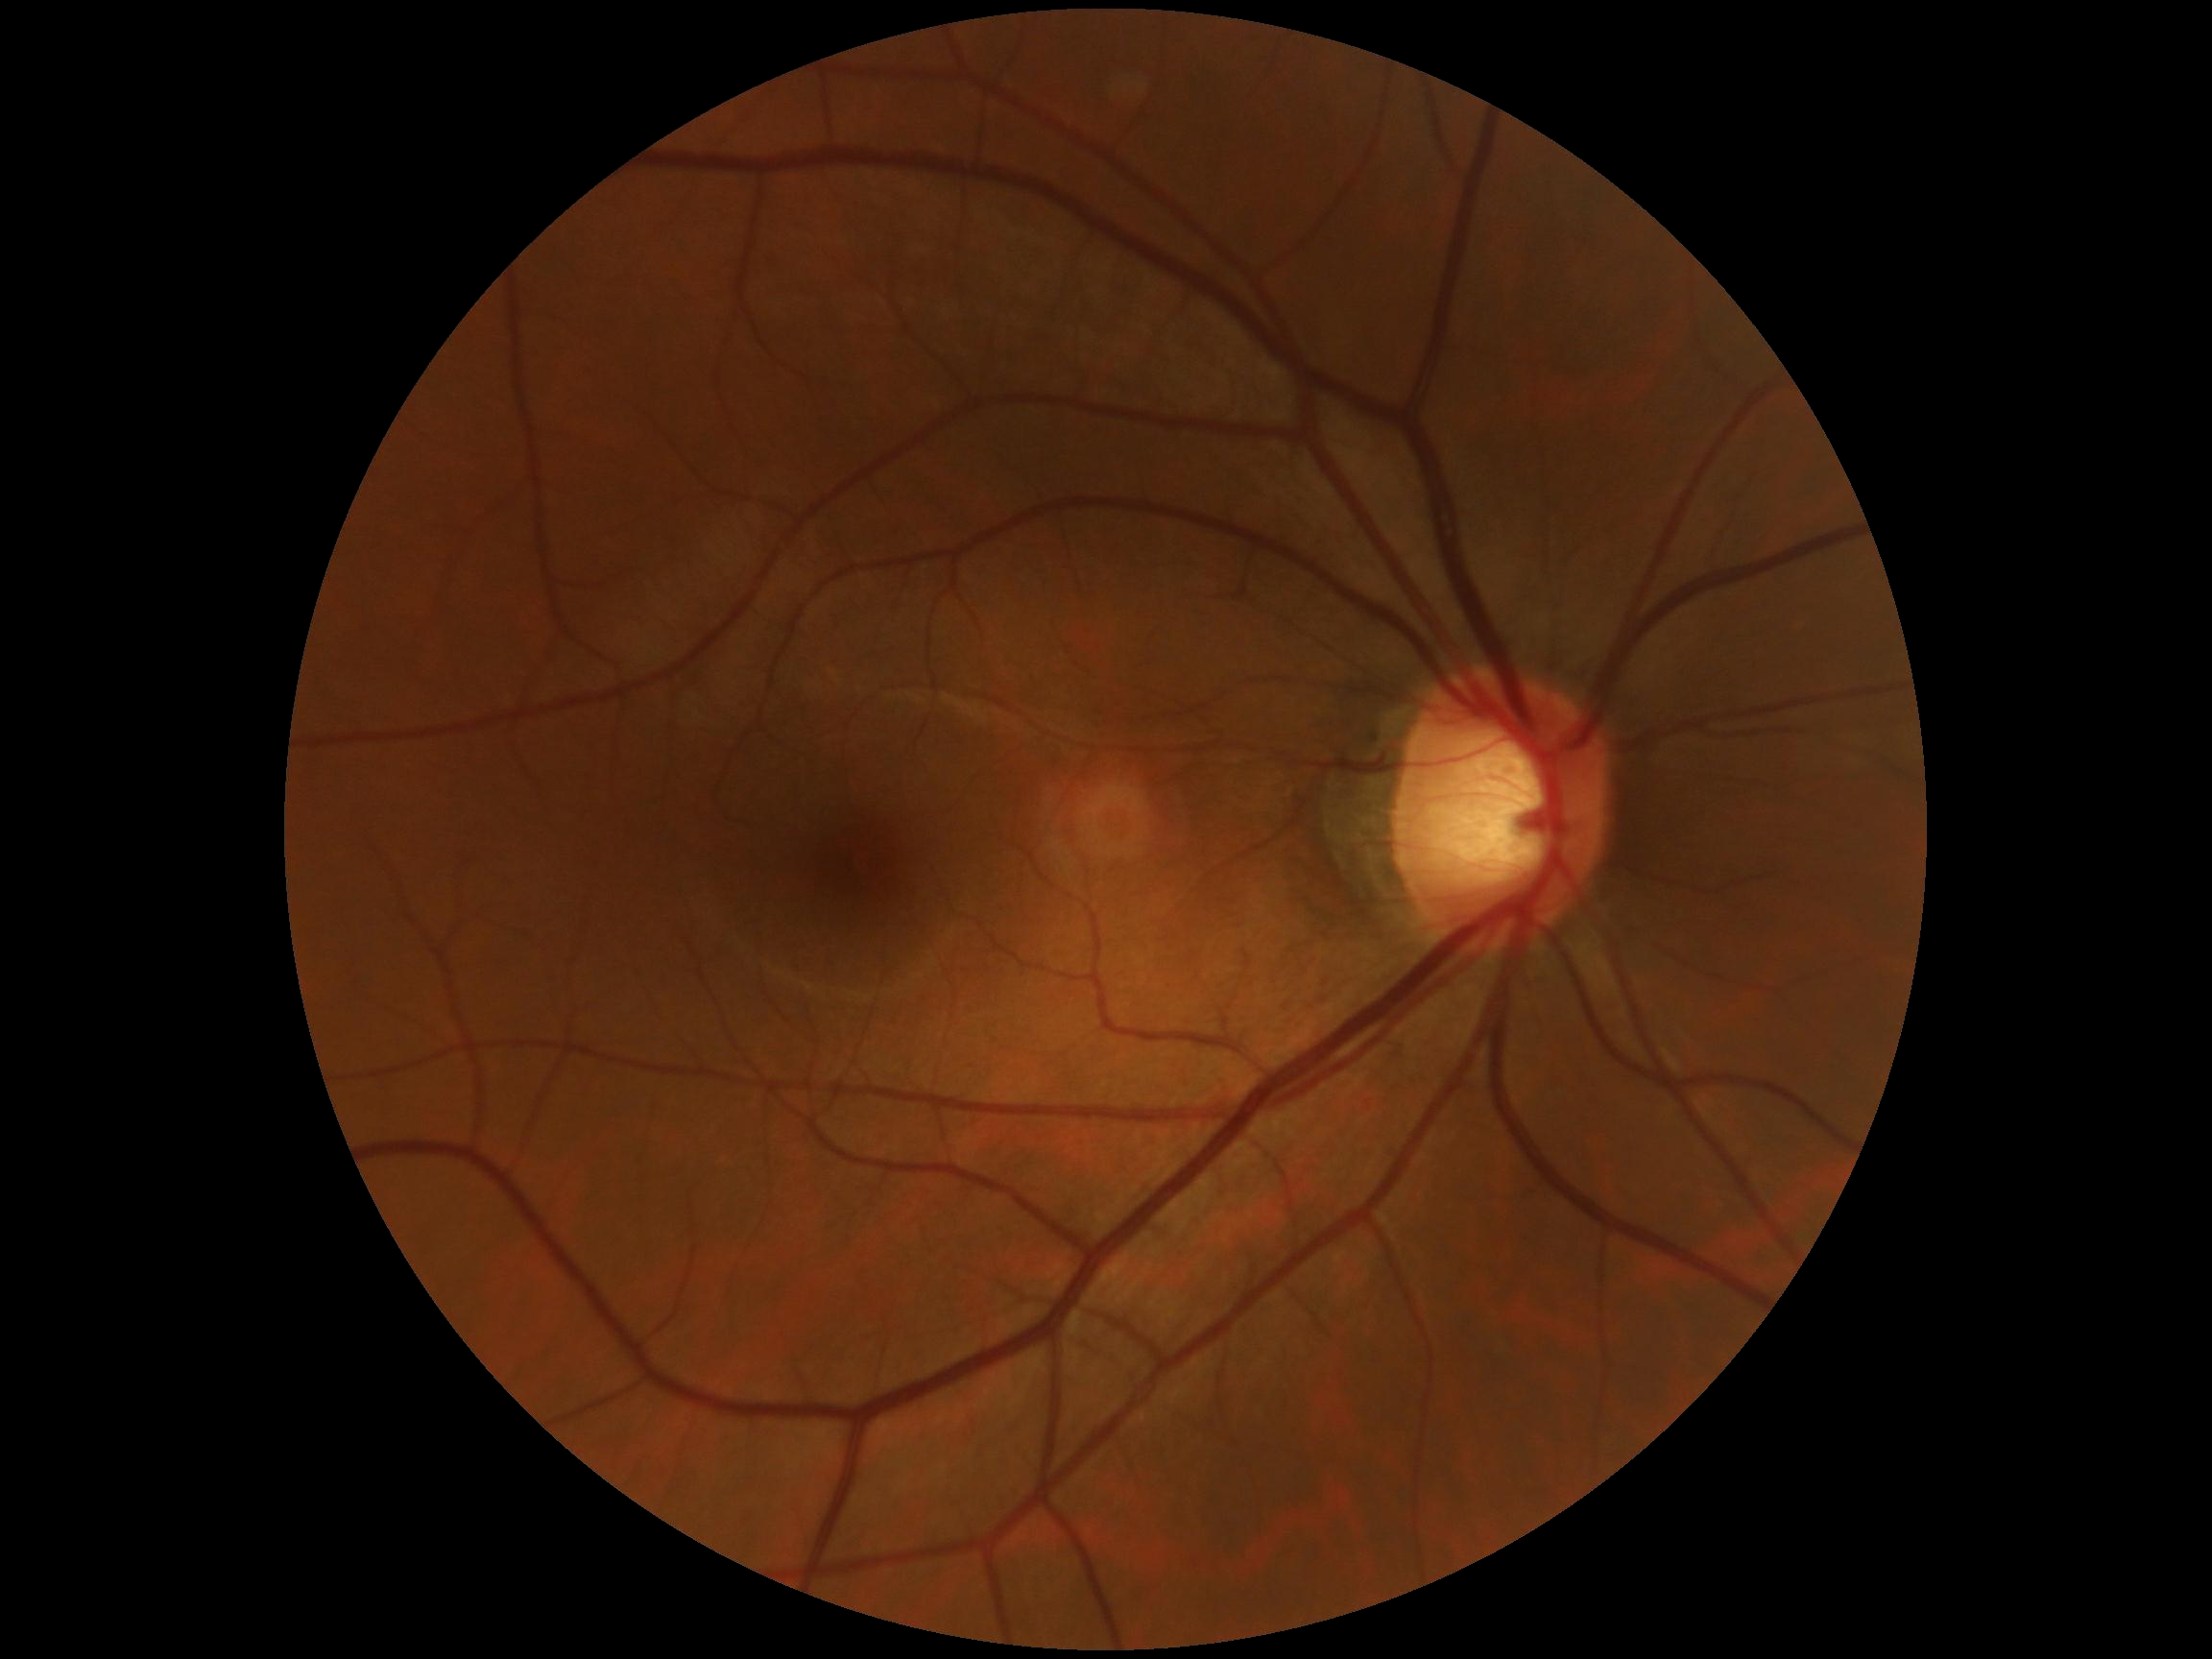

DR impression: no apparent DR | DR severity: grade 0.